Davis DR grading:
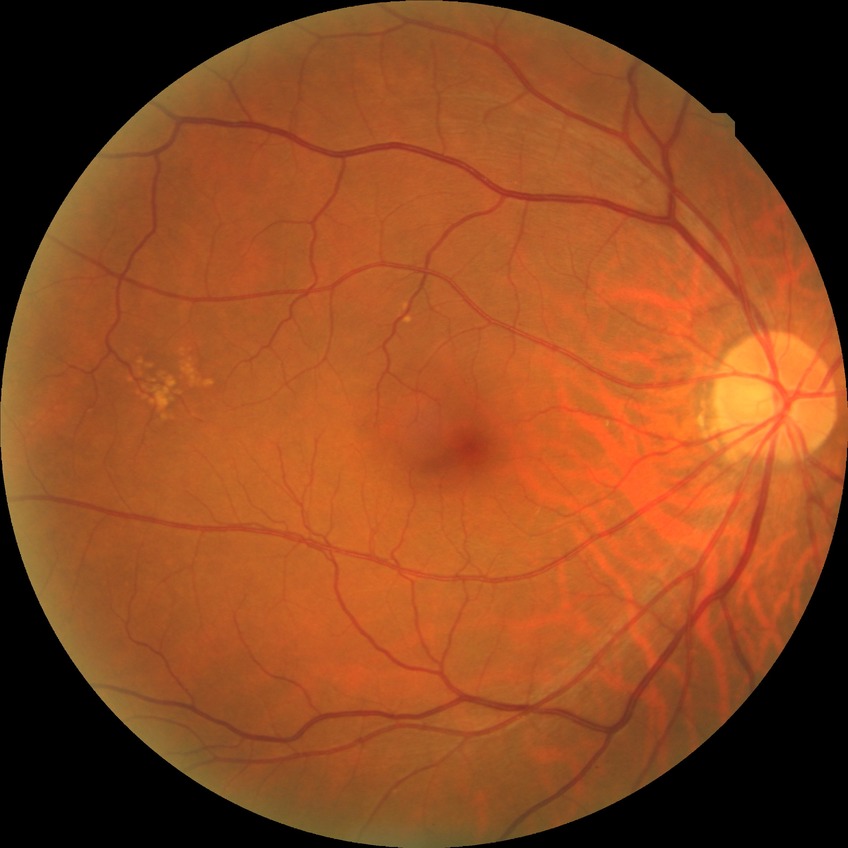 modified Davis classification = no diabetic retinopathy